Wide-field contact fundus photograph of an infant; 640x480px; captured with the Clarity RetCam 3 (130° field of view): 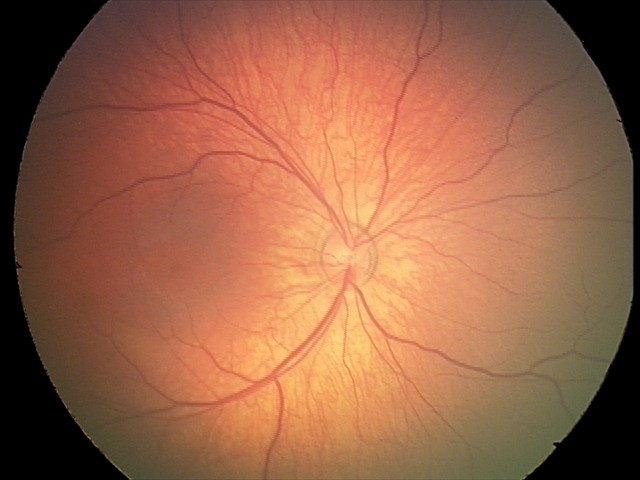

Impression: physiological appearance.